Infant wide-field fundus photograph. Acquired on the Phoenix ICON. 1240x1240: 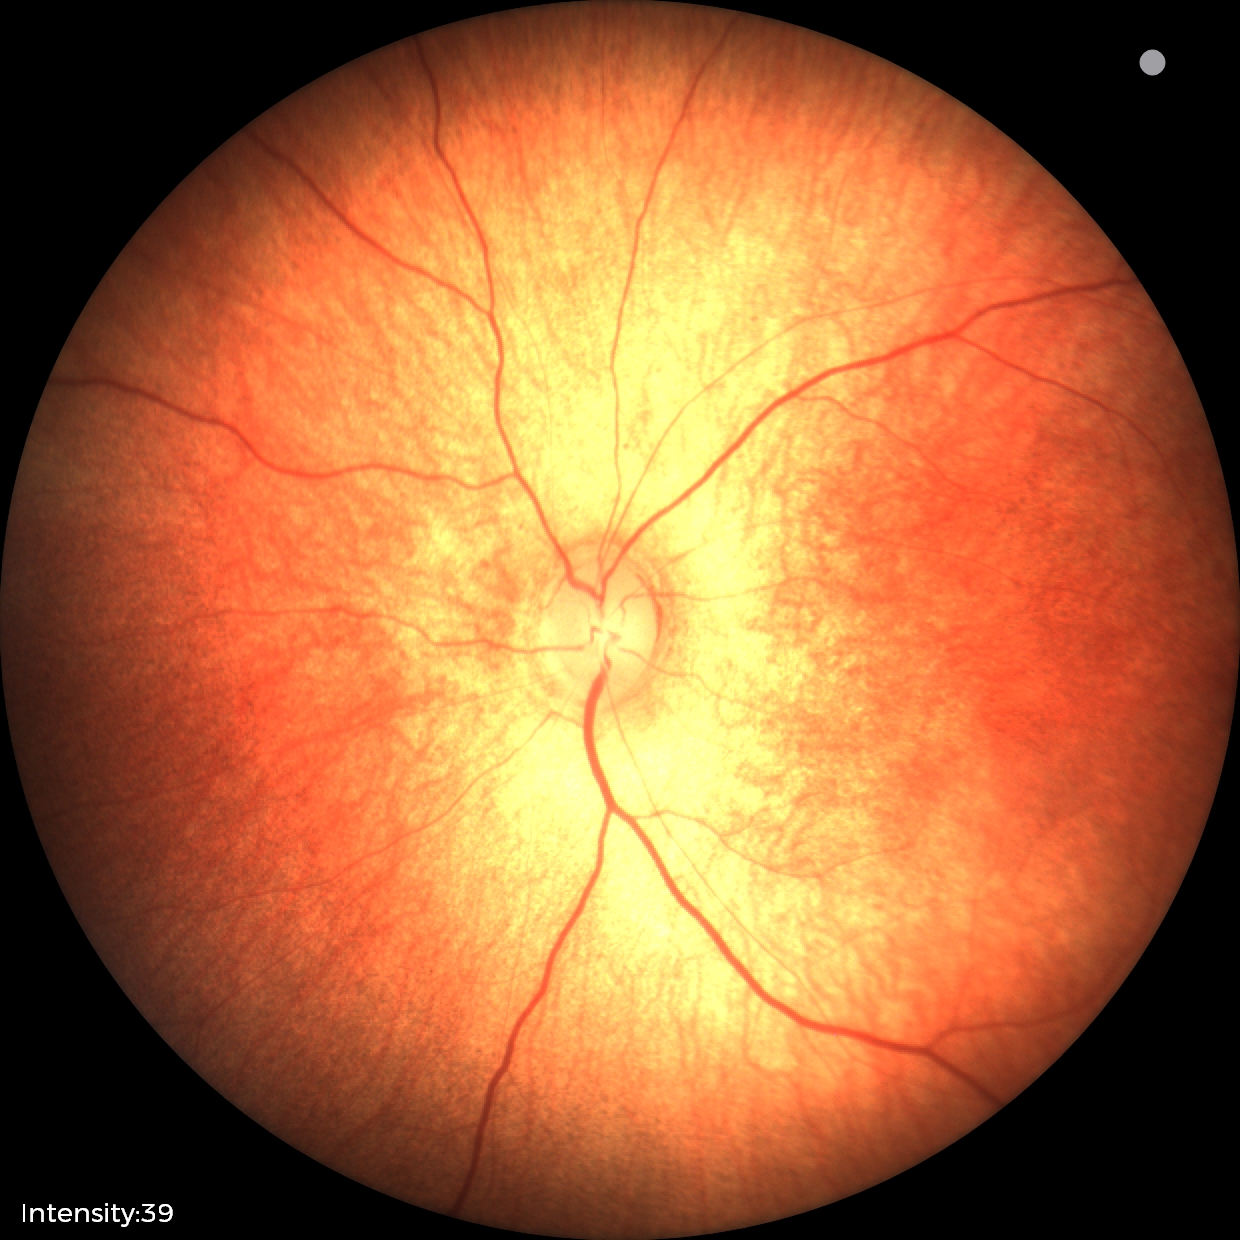 No retinal pathology identified on screening.